130° field of view (Natus RetCam Envision). Pediatric wide-field fundus photograph — 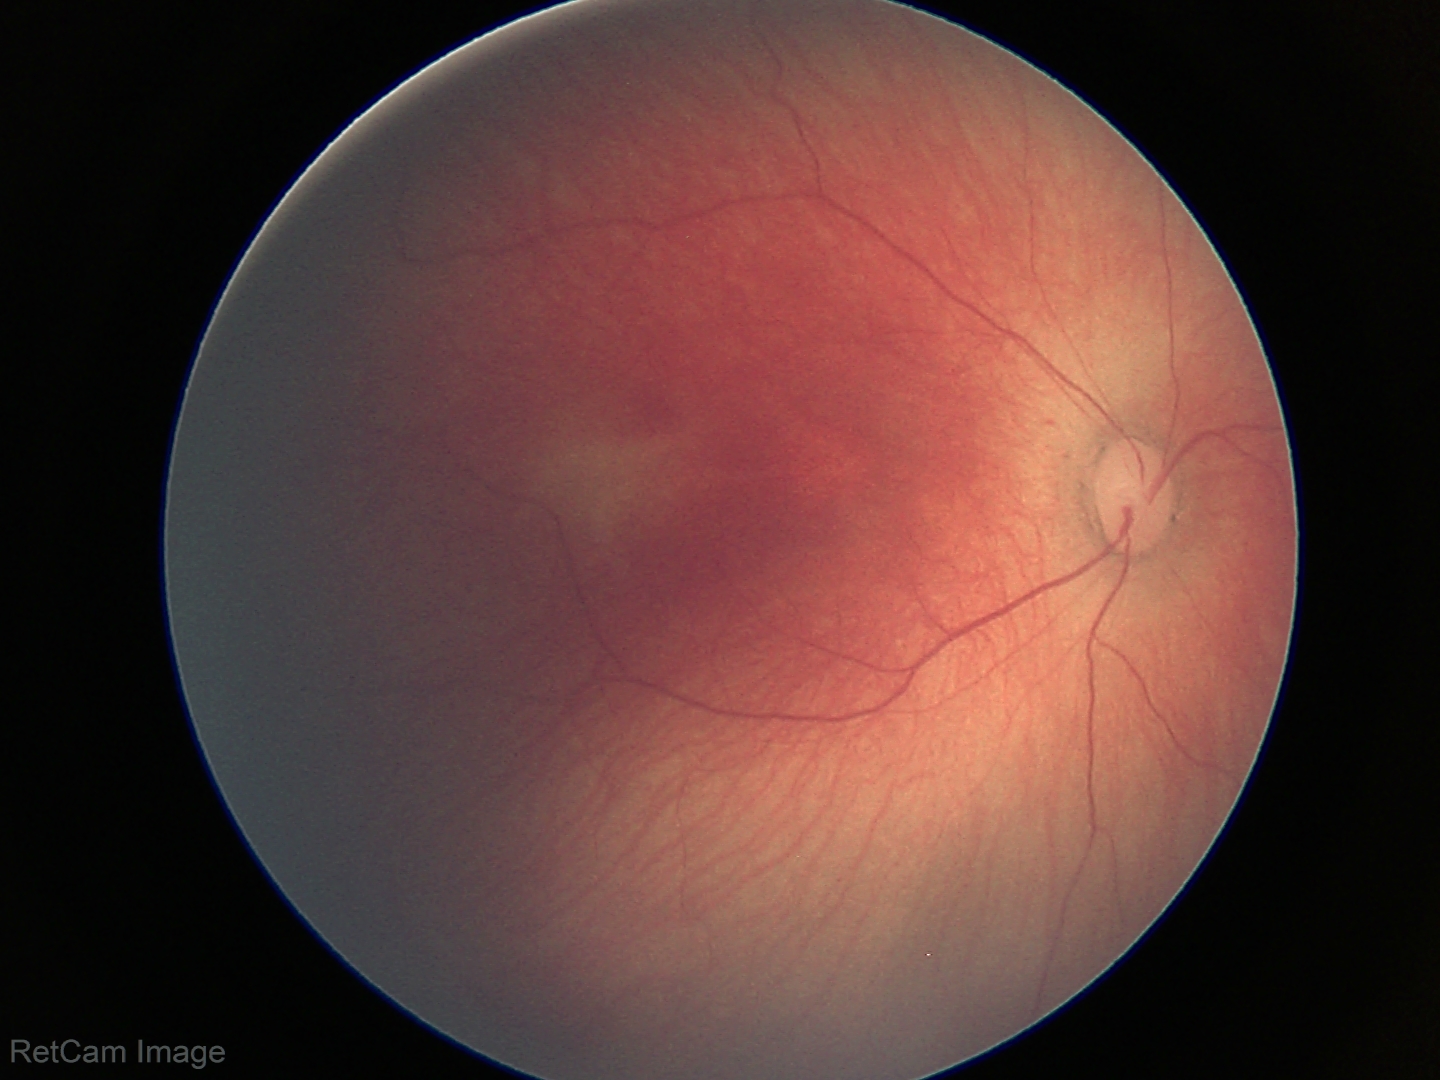

Without plus disease. Screening examination consistent with ROP stage 1.